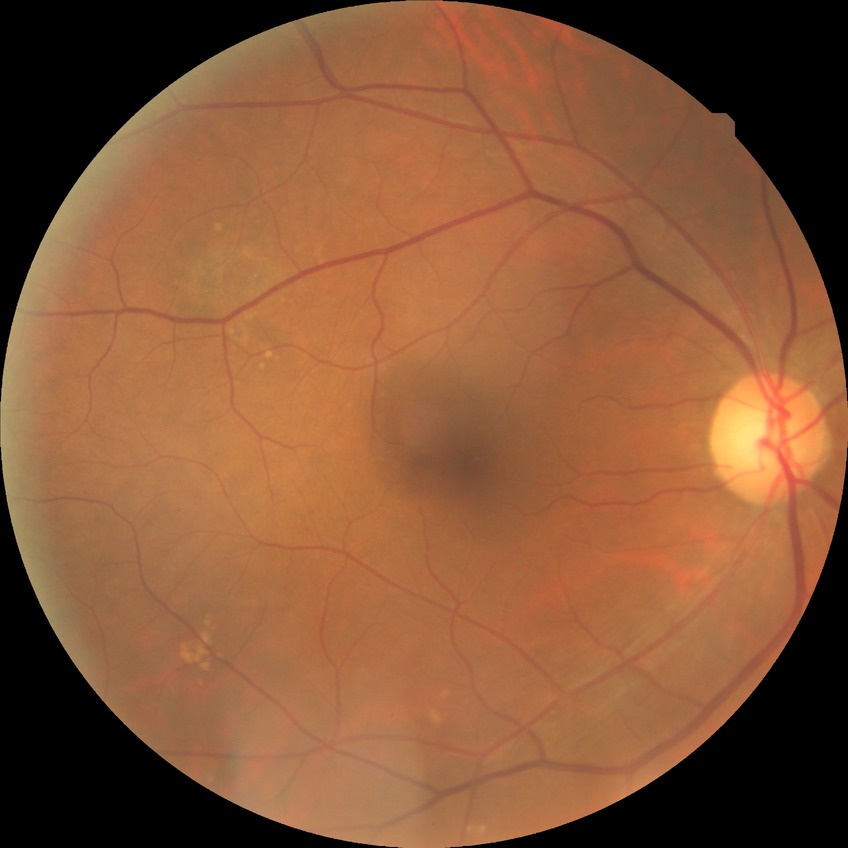
DR stage: NDR.